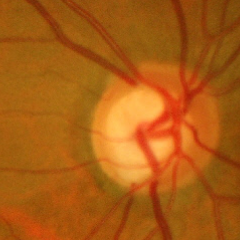

Fundus appearance consistent with advanced glaucoma.